Mydriatic (tropicamide and phenylephrine).
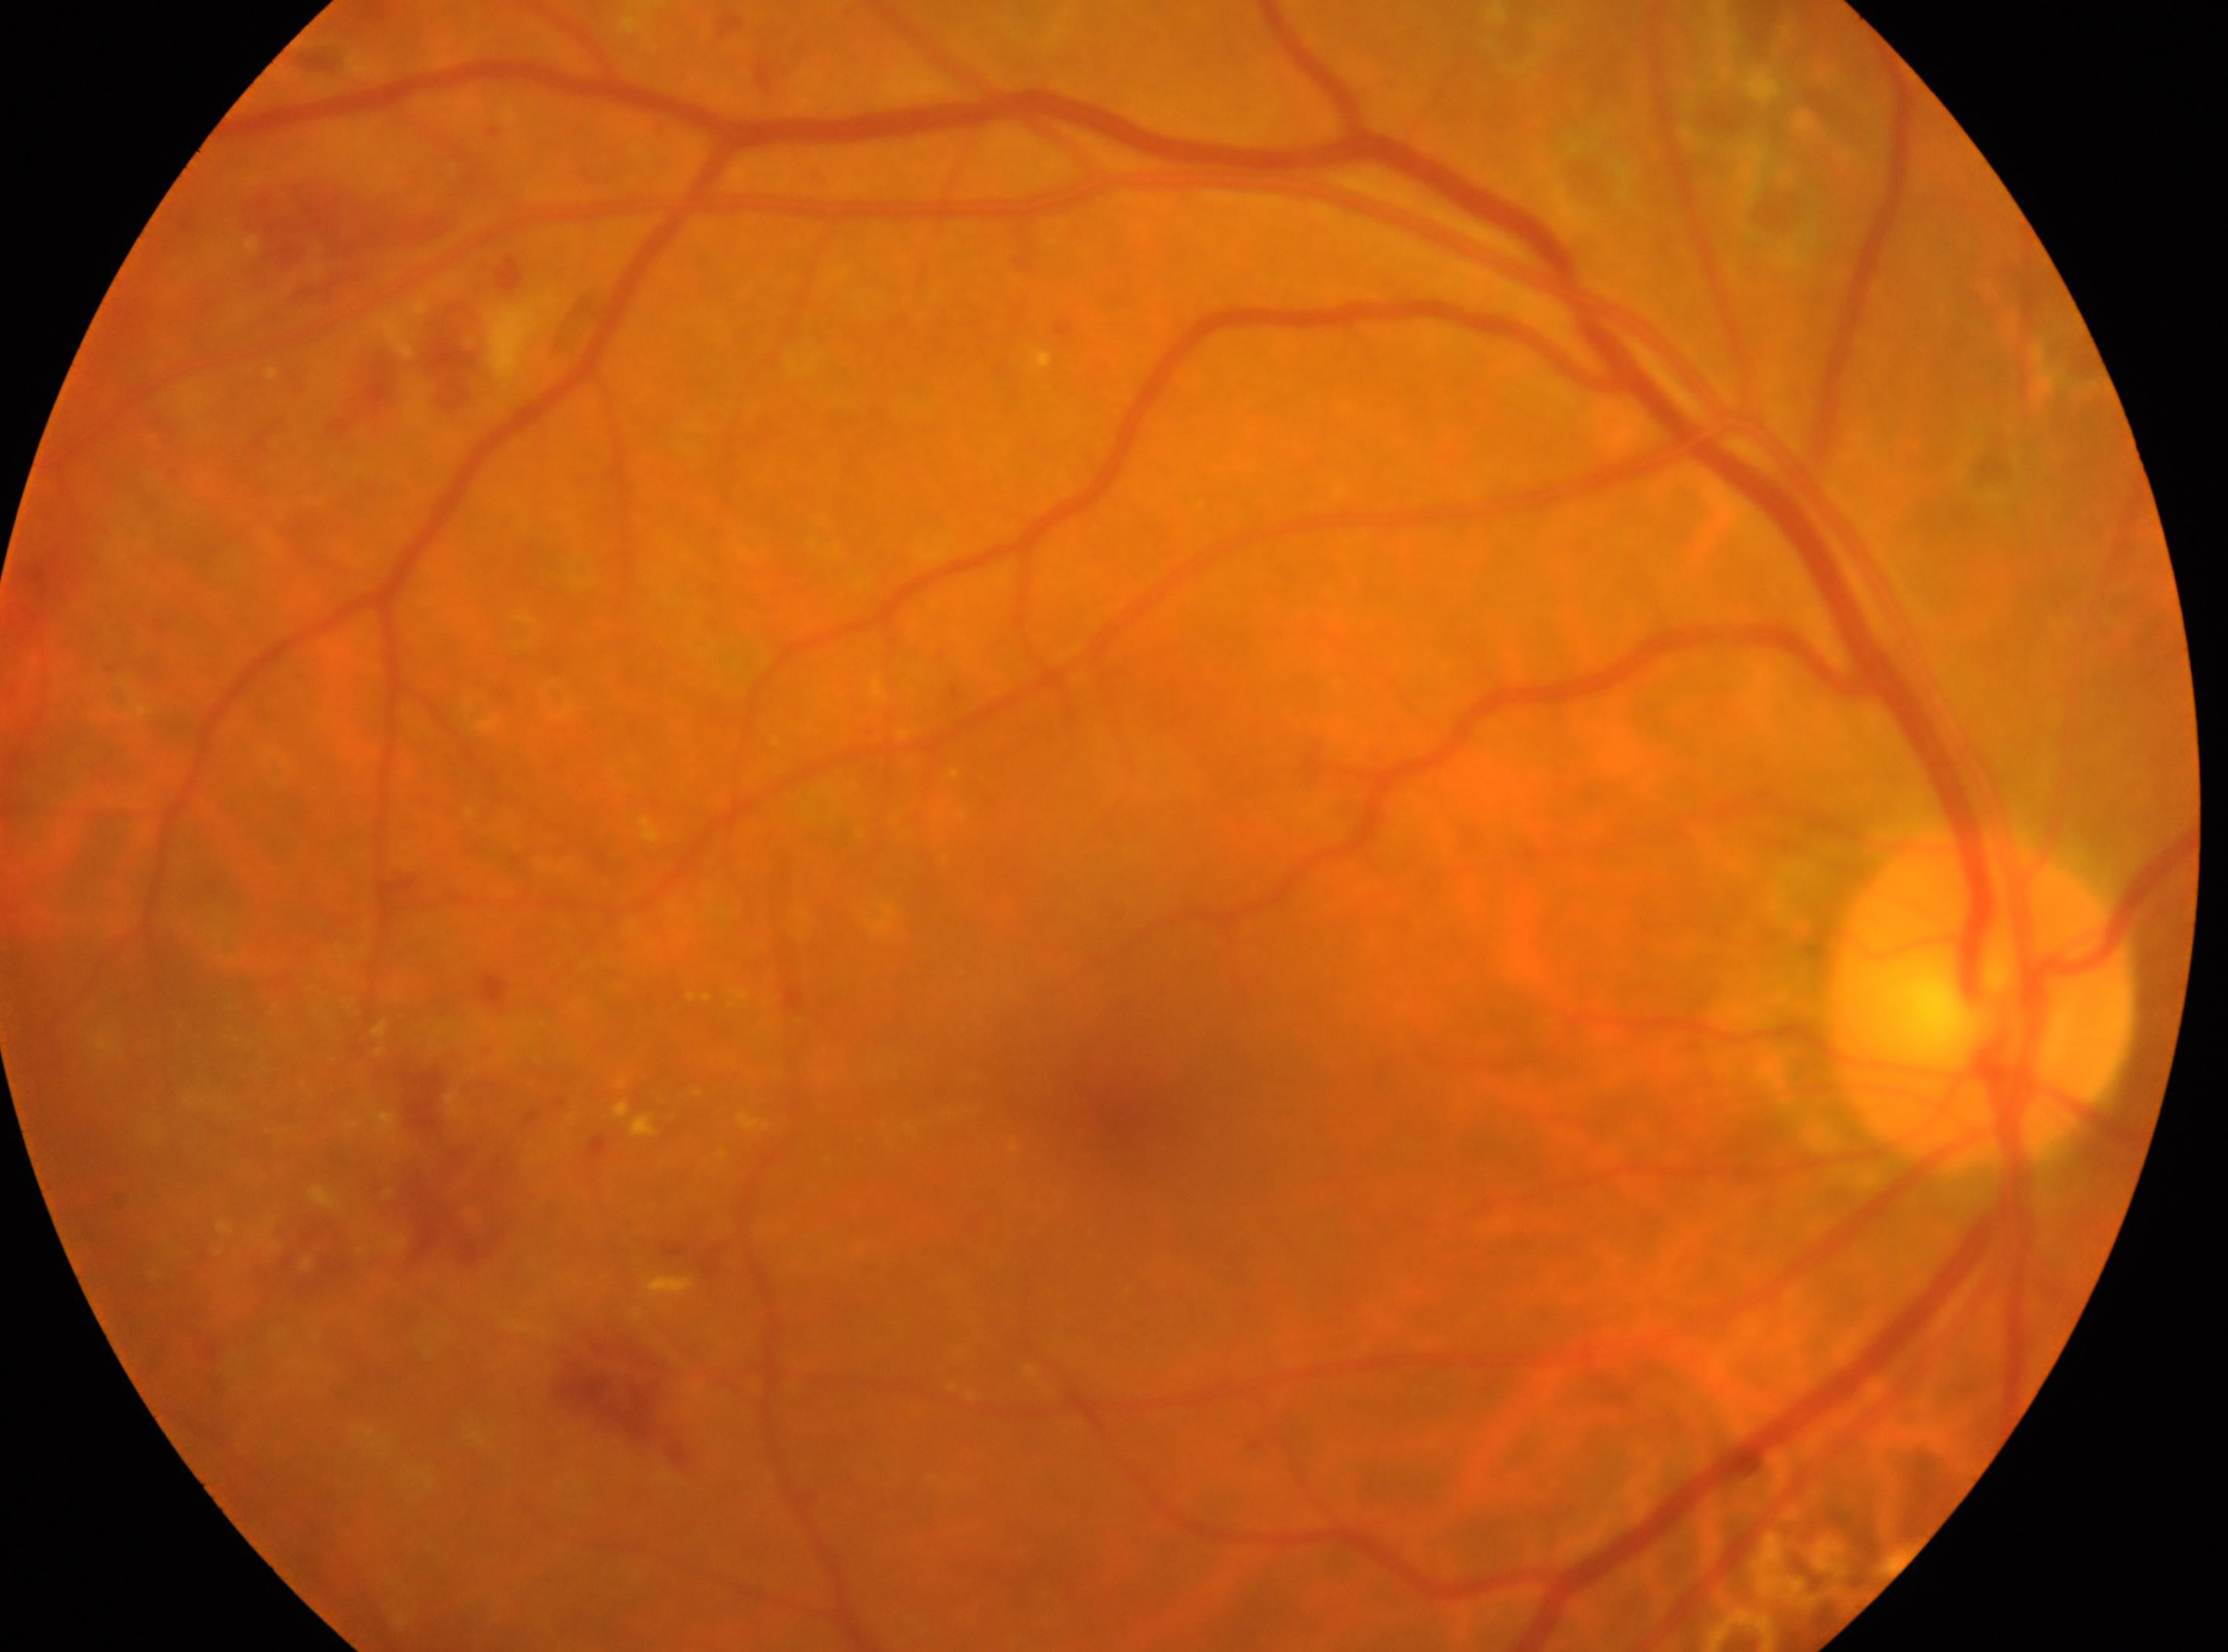
The image shows the OD. Foveal center: x=1128, y=1123. Optic disc: x=1977, y=1005. DR stage is post-photocoagulation DR, underlying severity moderate non-proliferative diabetic retinopathy (grade 2).